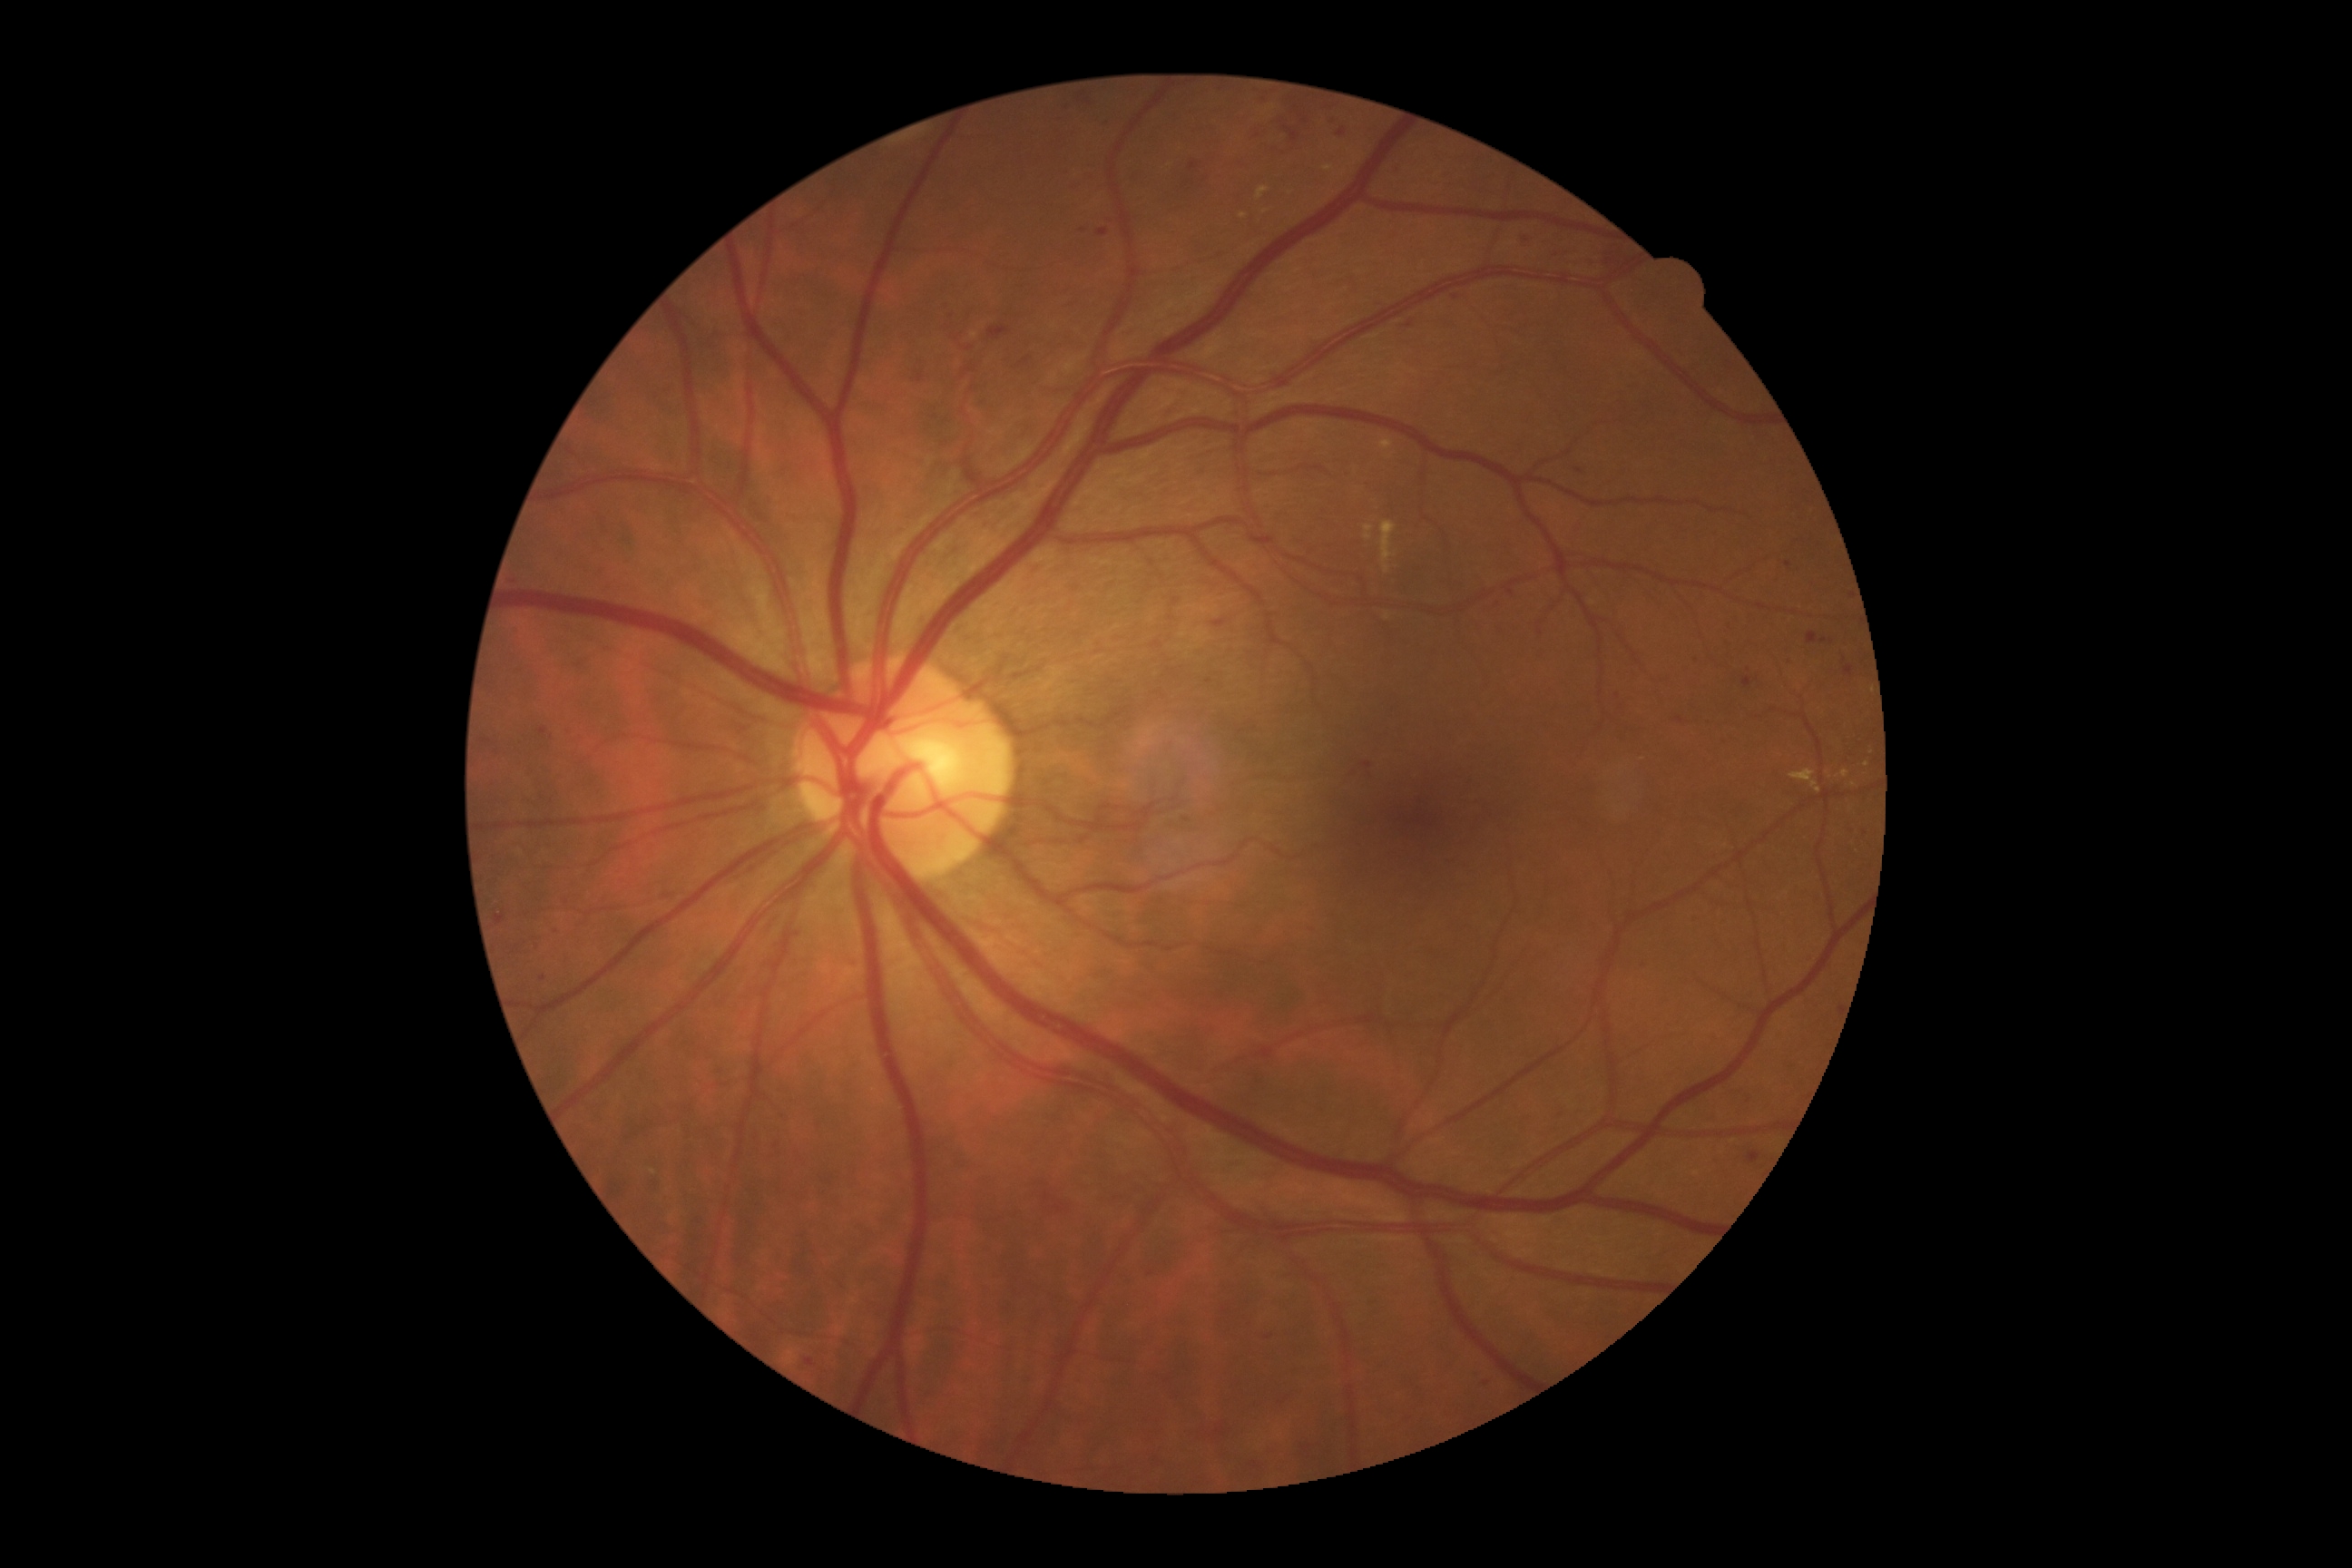 Diabetic retinopathy: grade 2 — more than just microaneurysms but less than severe NPDR
Representative lesions:
hard exudates (continued): (x1=1239, y1=213, x2=1248, y2=220), (x1=1364, y1=525, x2=1375, y2=542), (x1=1790, y1=770, x2=1821, y2=794), (x1=1322, y1=166, x2=1335, y2=172), (x1=1380, y1=522, x2=1396, y2=574), (x1=1380, y1=440, x2=1393, y2=451), (x1=1257, y1=188, x2=1269, y2=201), (x1=1384, y1=612, x2=1391, y2=622), (x1=1841, y1=770, x2=1850, y2=779)
Hard exudates (small, approximate centers) near [x=1866, y=766], [x=1266, y=211], [x=1854, y=785]
soft exudates: absent
microaneurysms: absent
hemorrhages (continued): (x1=1338, y1=128, x2=1346, y2=137), (x1=509, y1=574, x2=522, y2=589), (x1=598, y1=567, x2=609, y2=576), (x1=1259, y1=1329, x2=1284, y2=1344), (x1=1781, y1=649, x2=1794, y2=667), (x1=939, y1=299, x2=1014, y2=355), (x1=1690, y1=656, x2=1701, y2=667), (x1=1152, y1=642, x2=1162, y2=649), (x1=1845, y1=667, x2=1854, y2=678), (x1=1465, y1=1367, x2=1498, y2=1396), (x1=790, y1=1257, x2=819, y2=1282), (x1=1534, y1=649, x2=1547, y2=662), (x1=801, y1=1355, x2=818, y2=1371), (x1=1077, y1=93, x2=1095, y2=112), (x1=564, y1=894, x2=576, y2=905)
Hemorrhages (small, approximate centers) near [x=1455, y=298], [x=1027, y=360], [x=1208, y=682], [x=1151, y=1275]